Phoenix ICON wide-field infant fundus image; acquired on the Phoenix ICON — 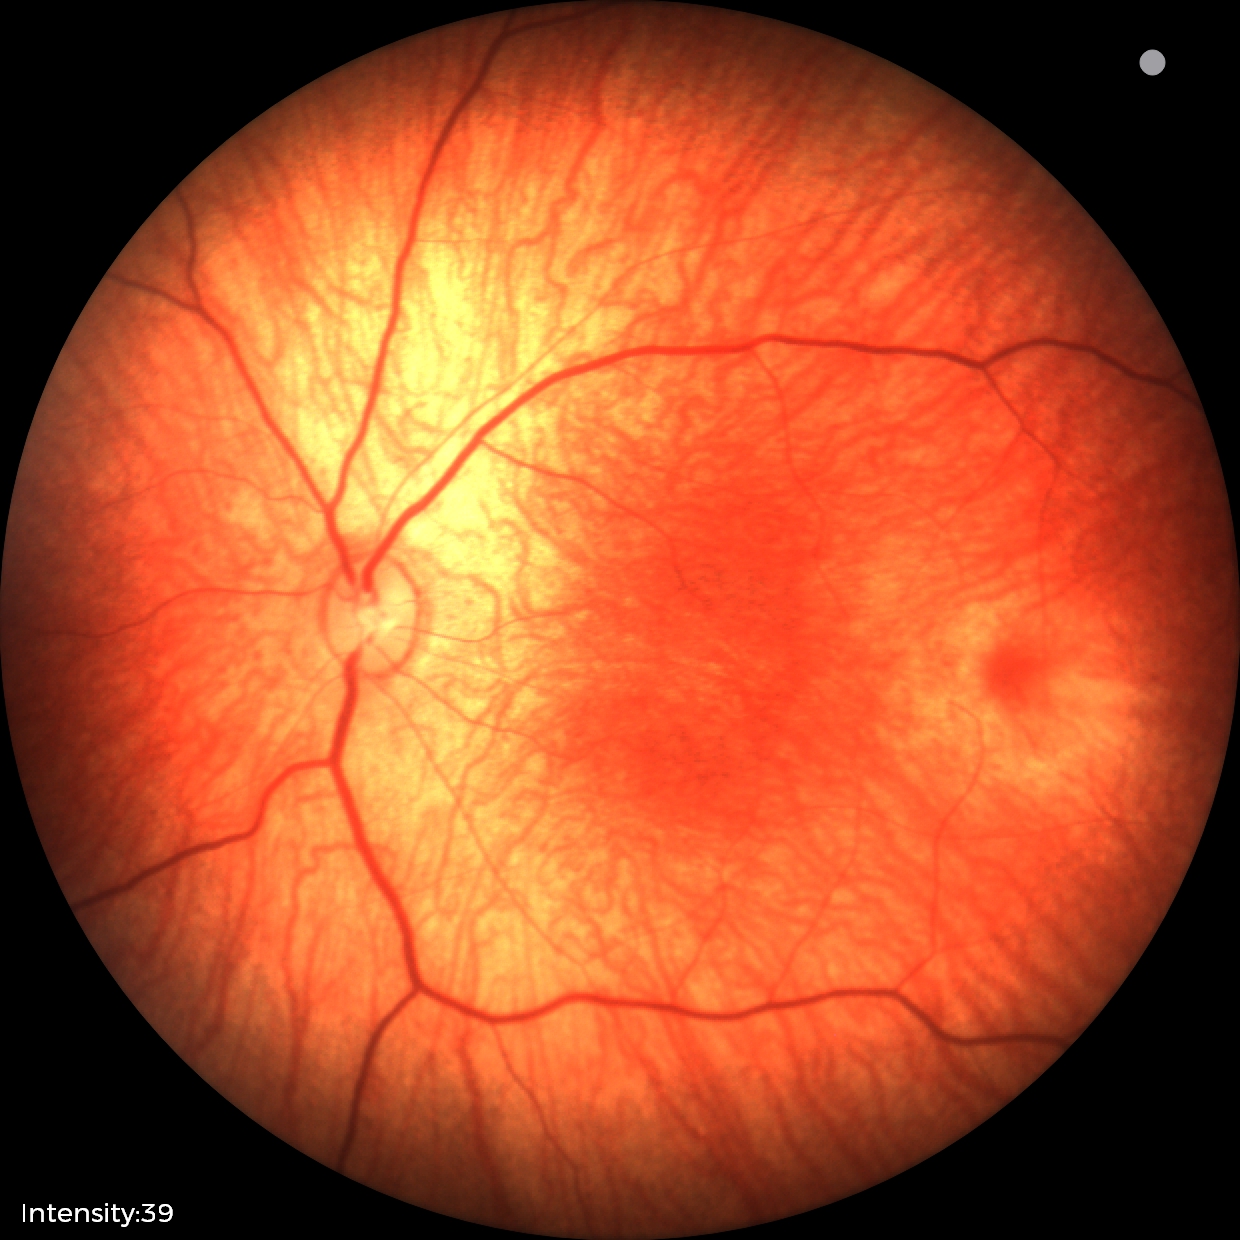

Screening: physiological appearance with no retinal pathology.